Captured with the Phoenix ICON (100° field of view) · pediatric retinal photograph (wide-field) — 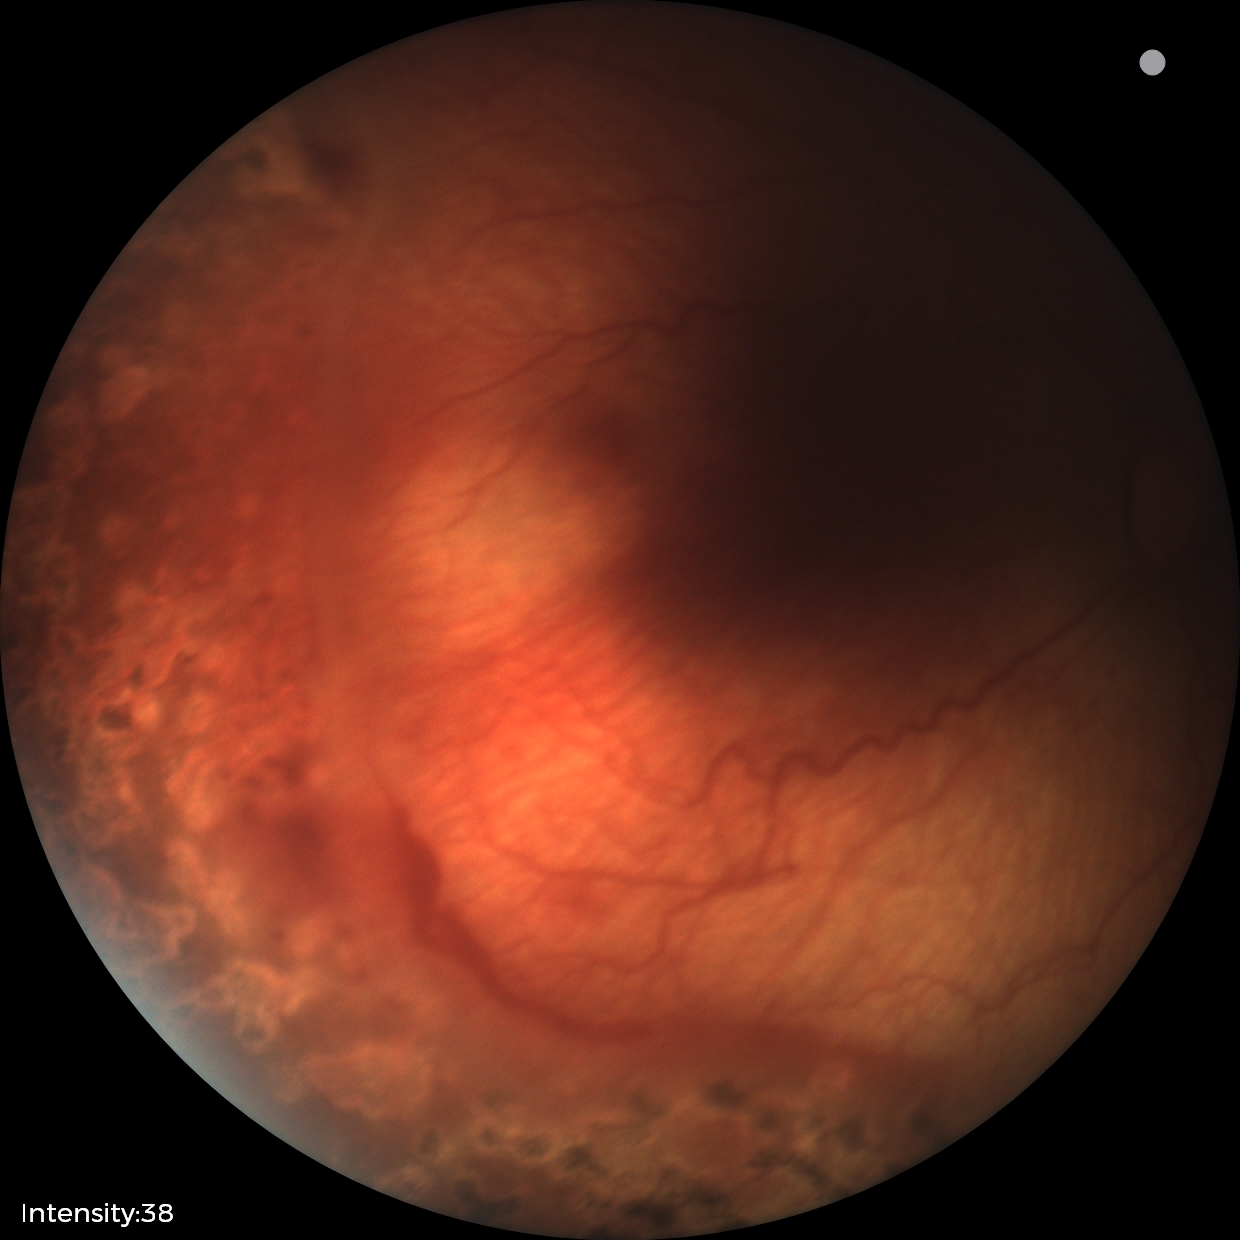
Without plus disease. Examination diagnosed as status post retinopathy of prematurity.